Camera: NIDEK AFC-230; 45 degree fundus photograph.
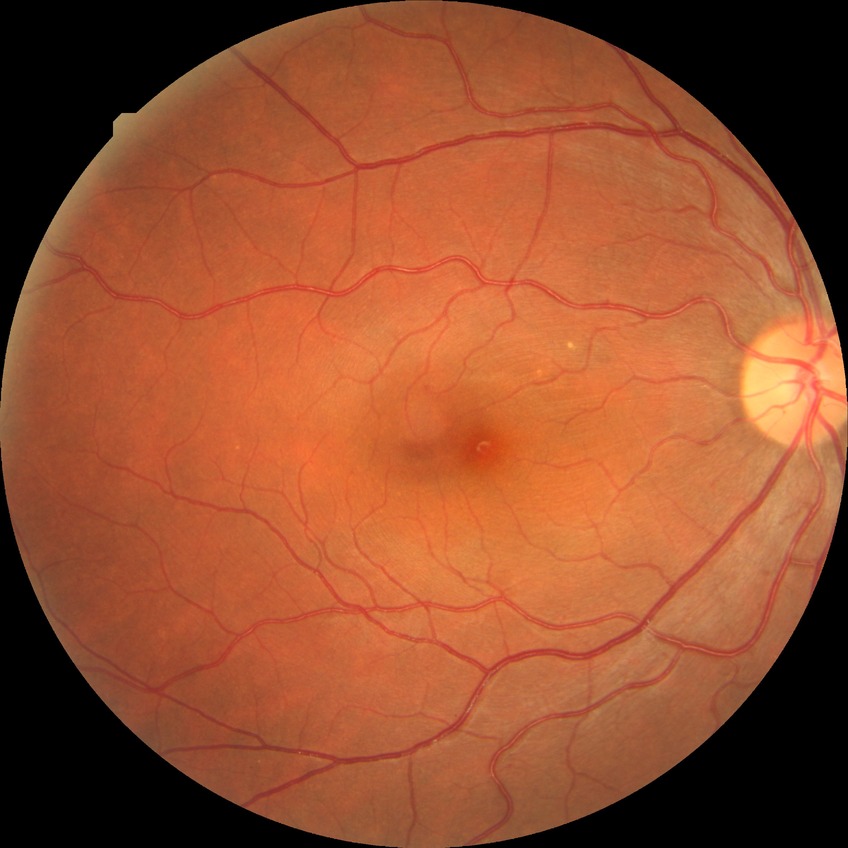 Modified Davis classification: no diabetic retinopathy.